FOV: 45 degrees. CFP. NIDEK AFC-230 fundus camera
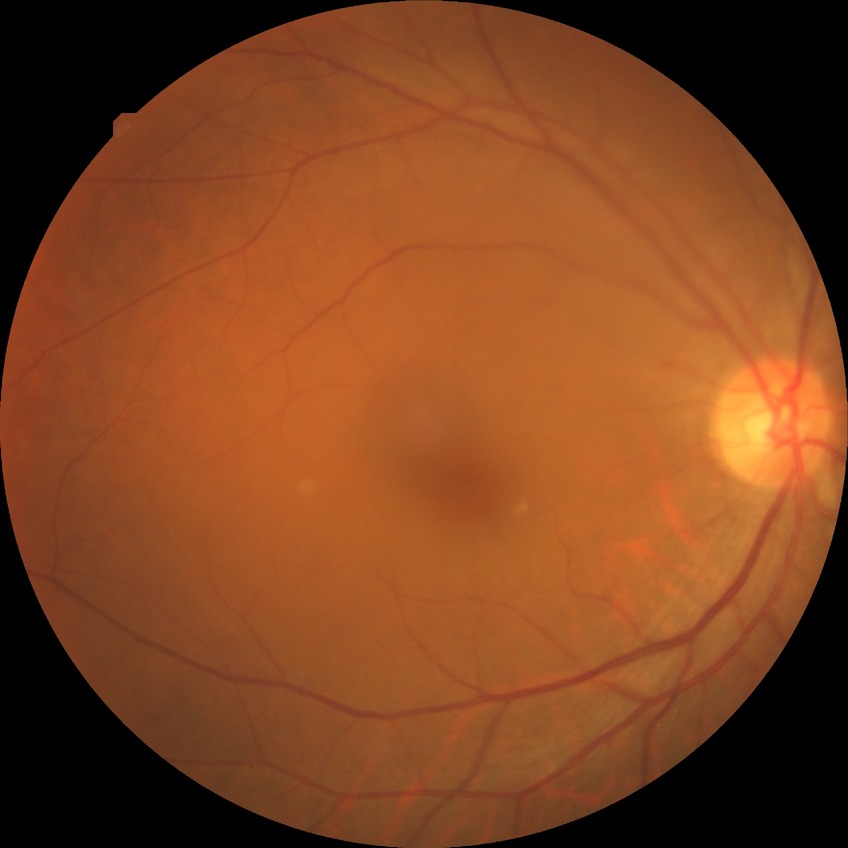

Diabetic retinopathy grade: no diabetic retinopathy.